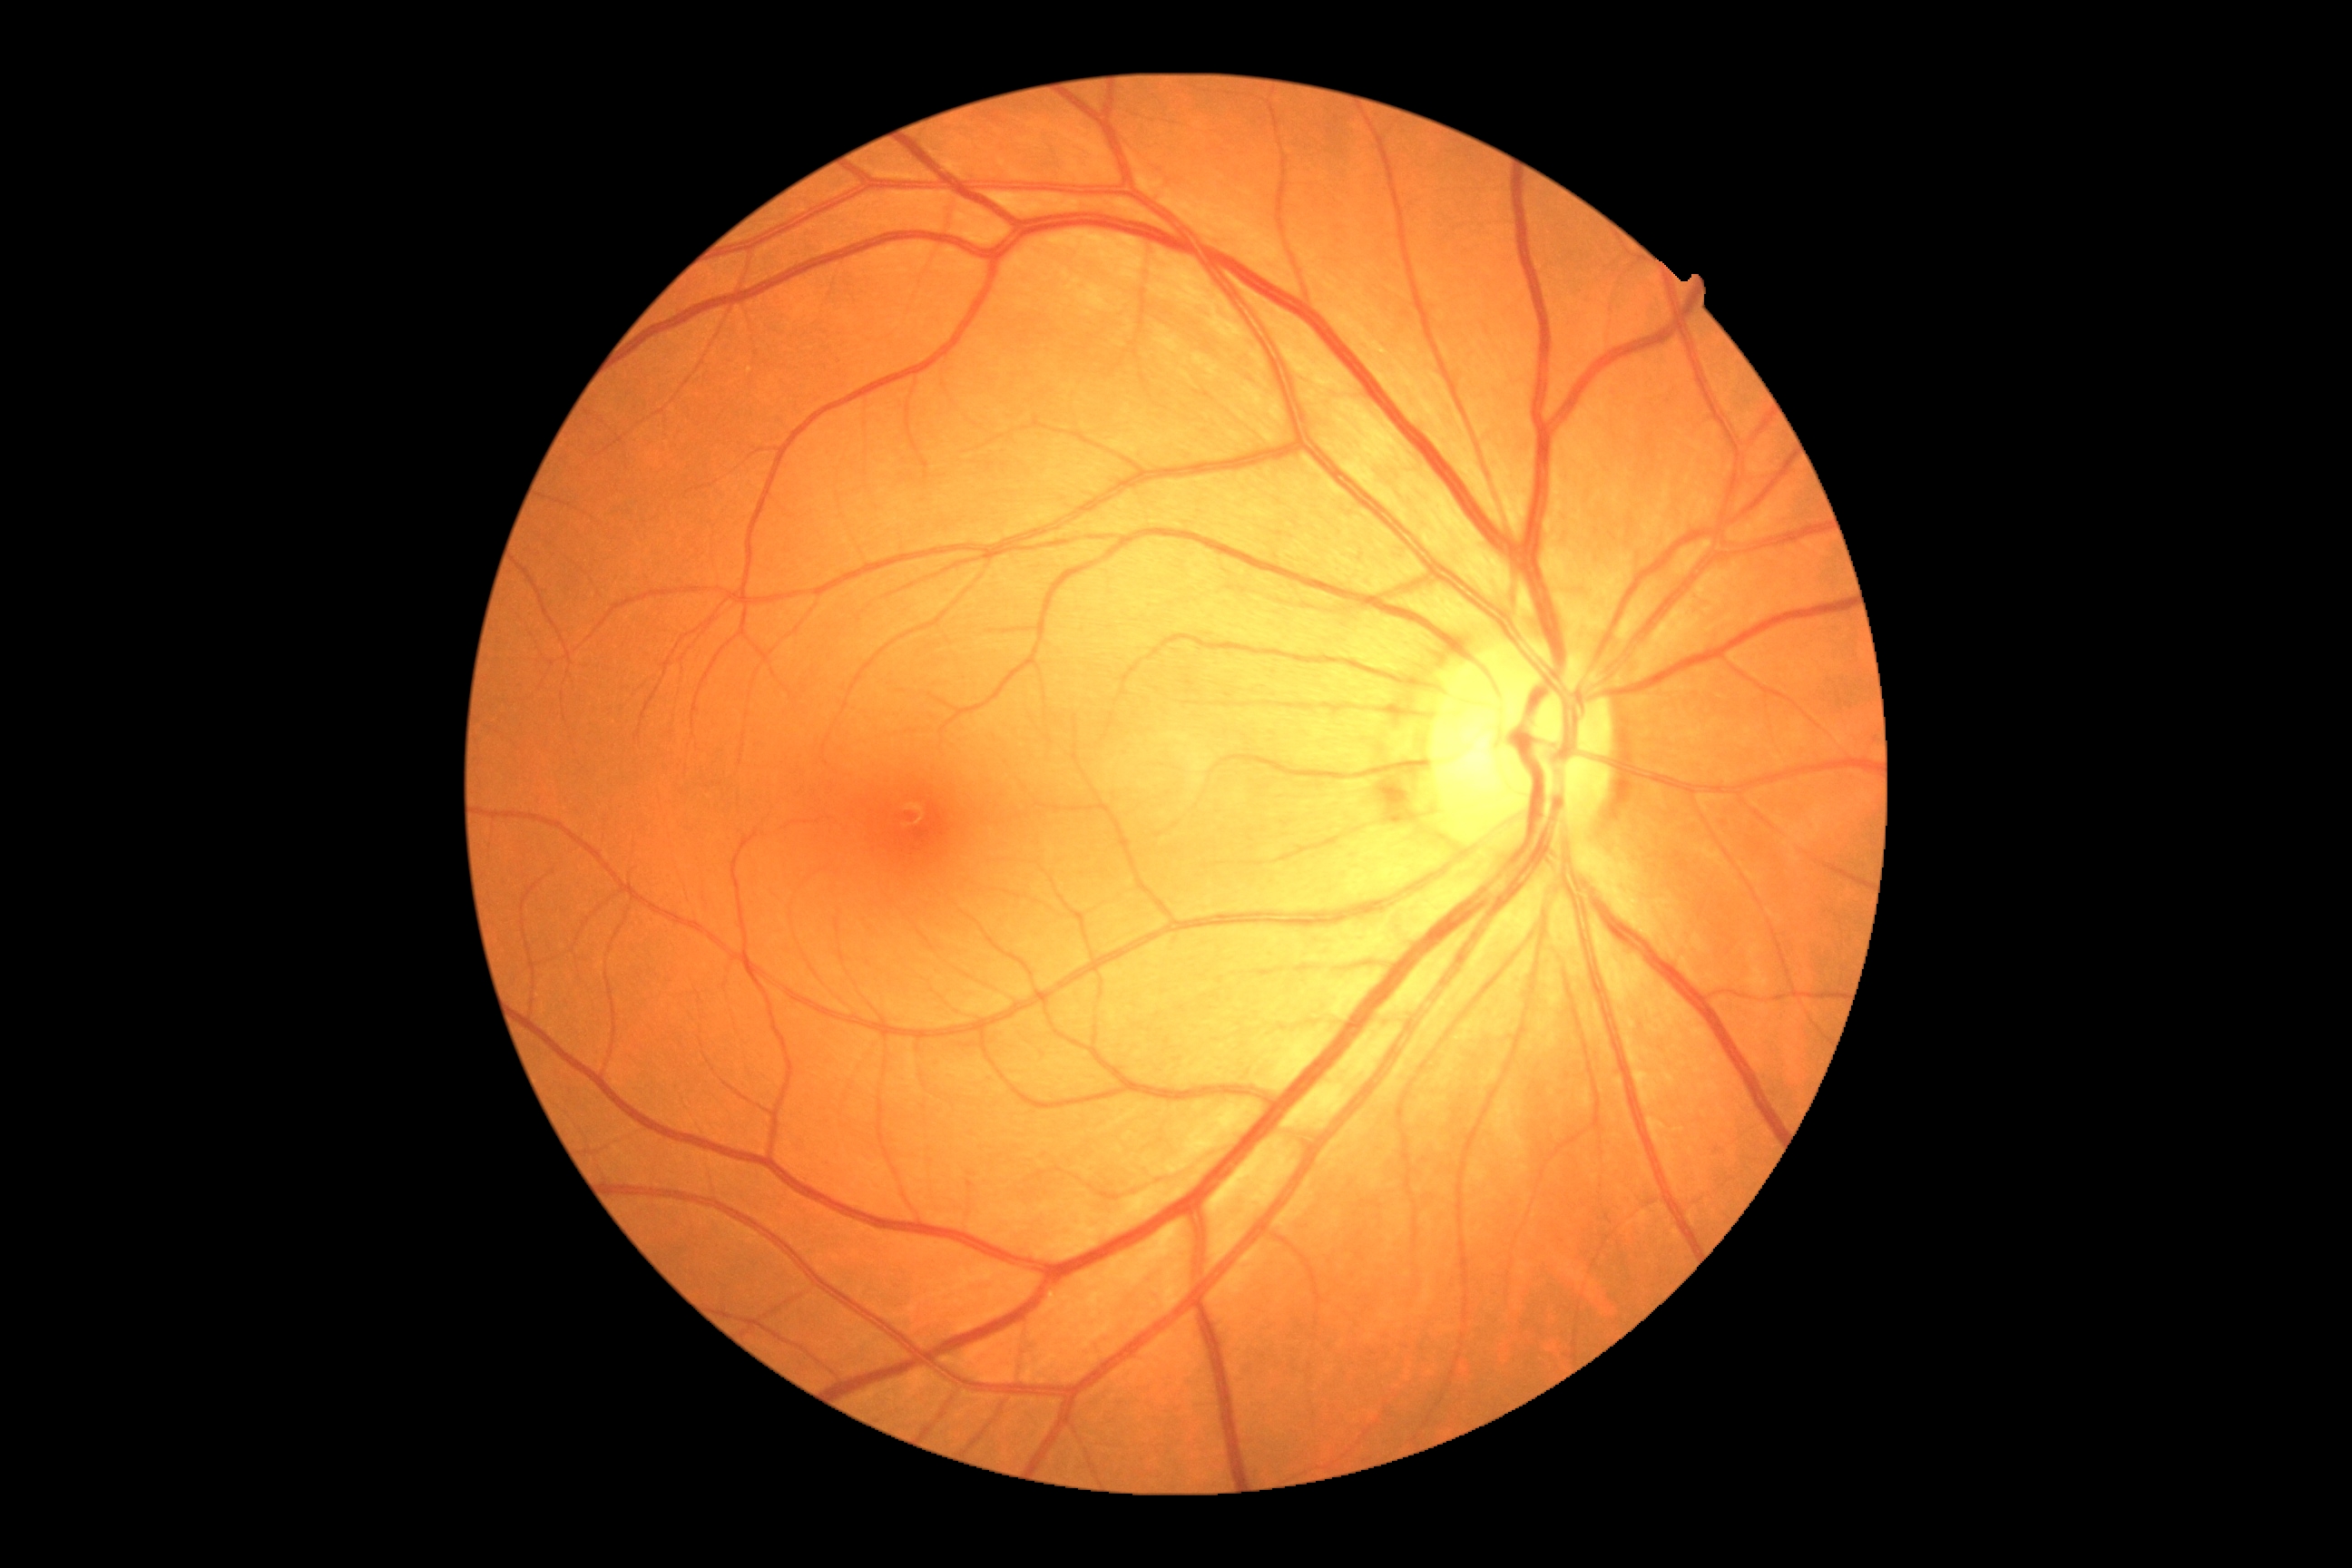 DR grade: 0 — no visible signs of diabetic retinopathy.